Color fundus photograph.
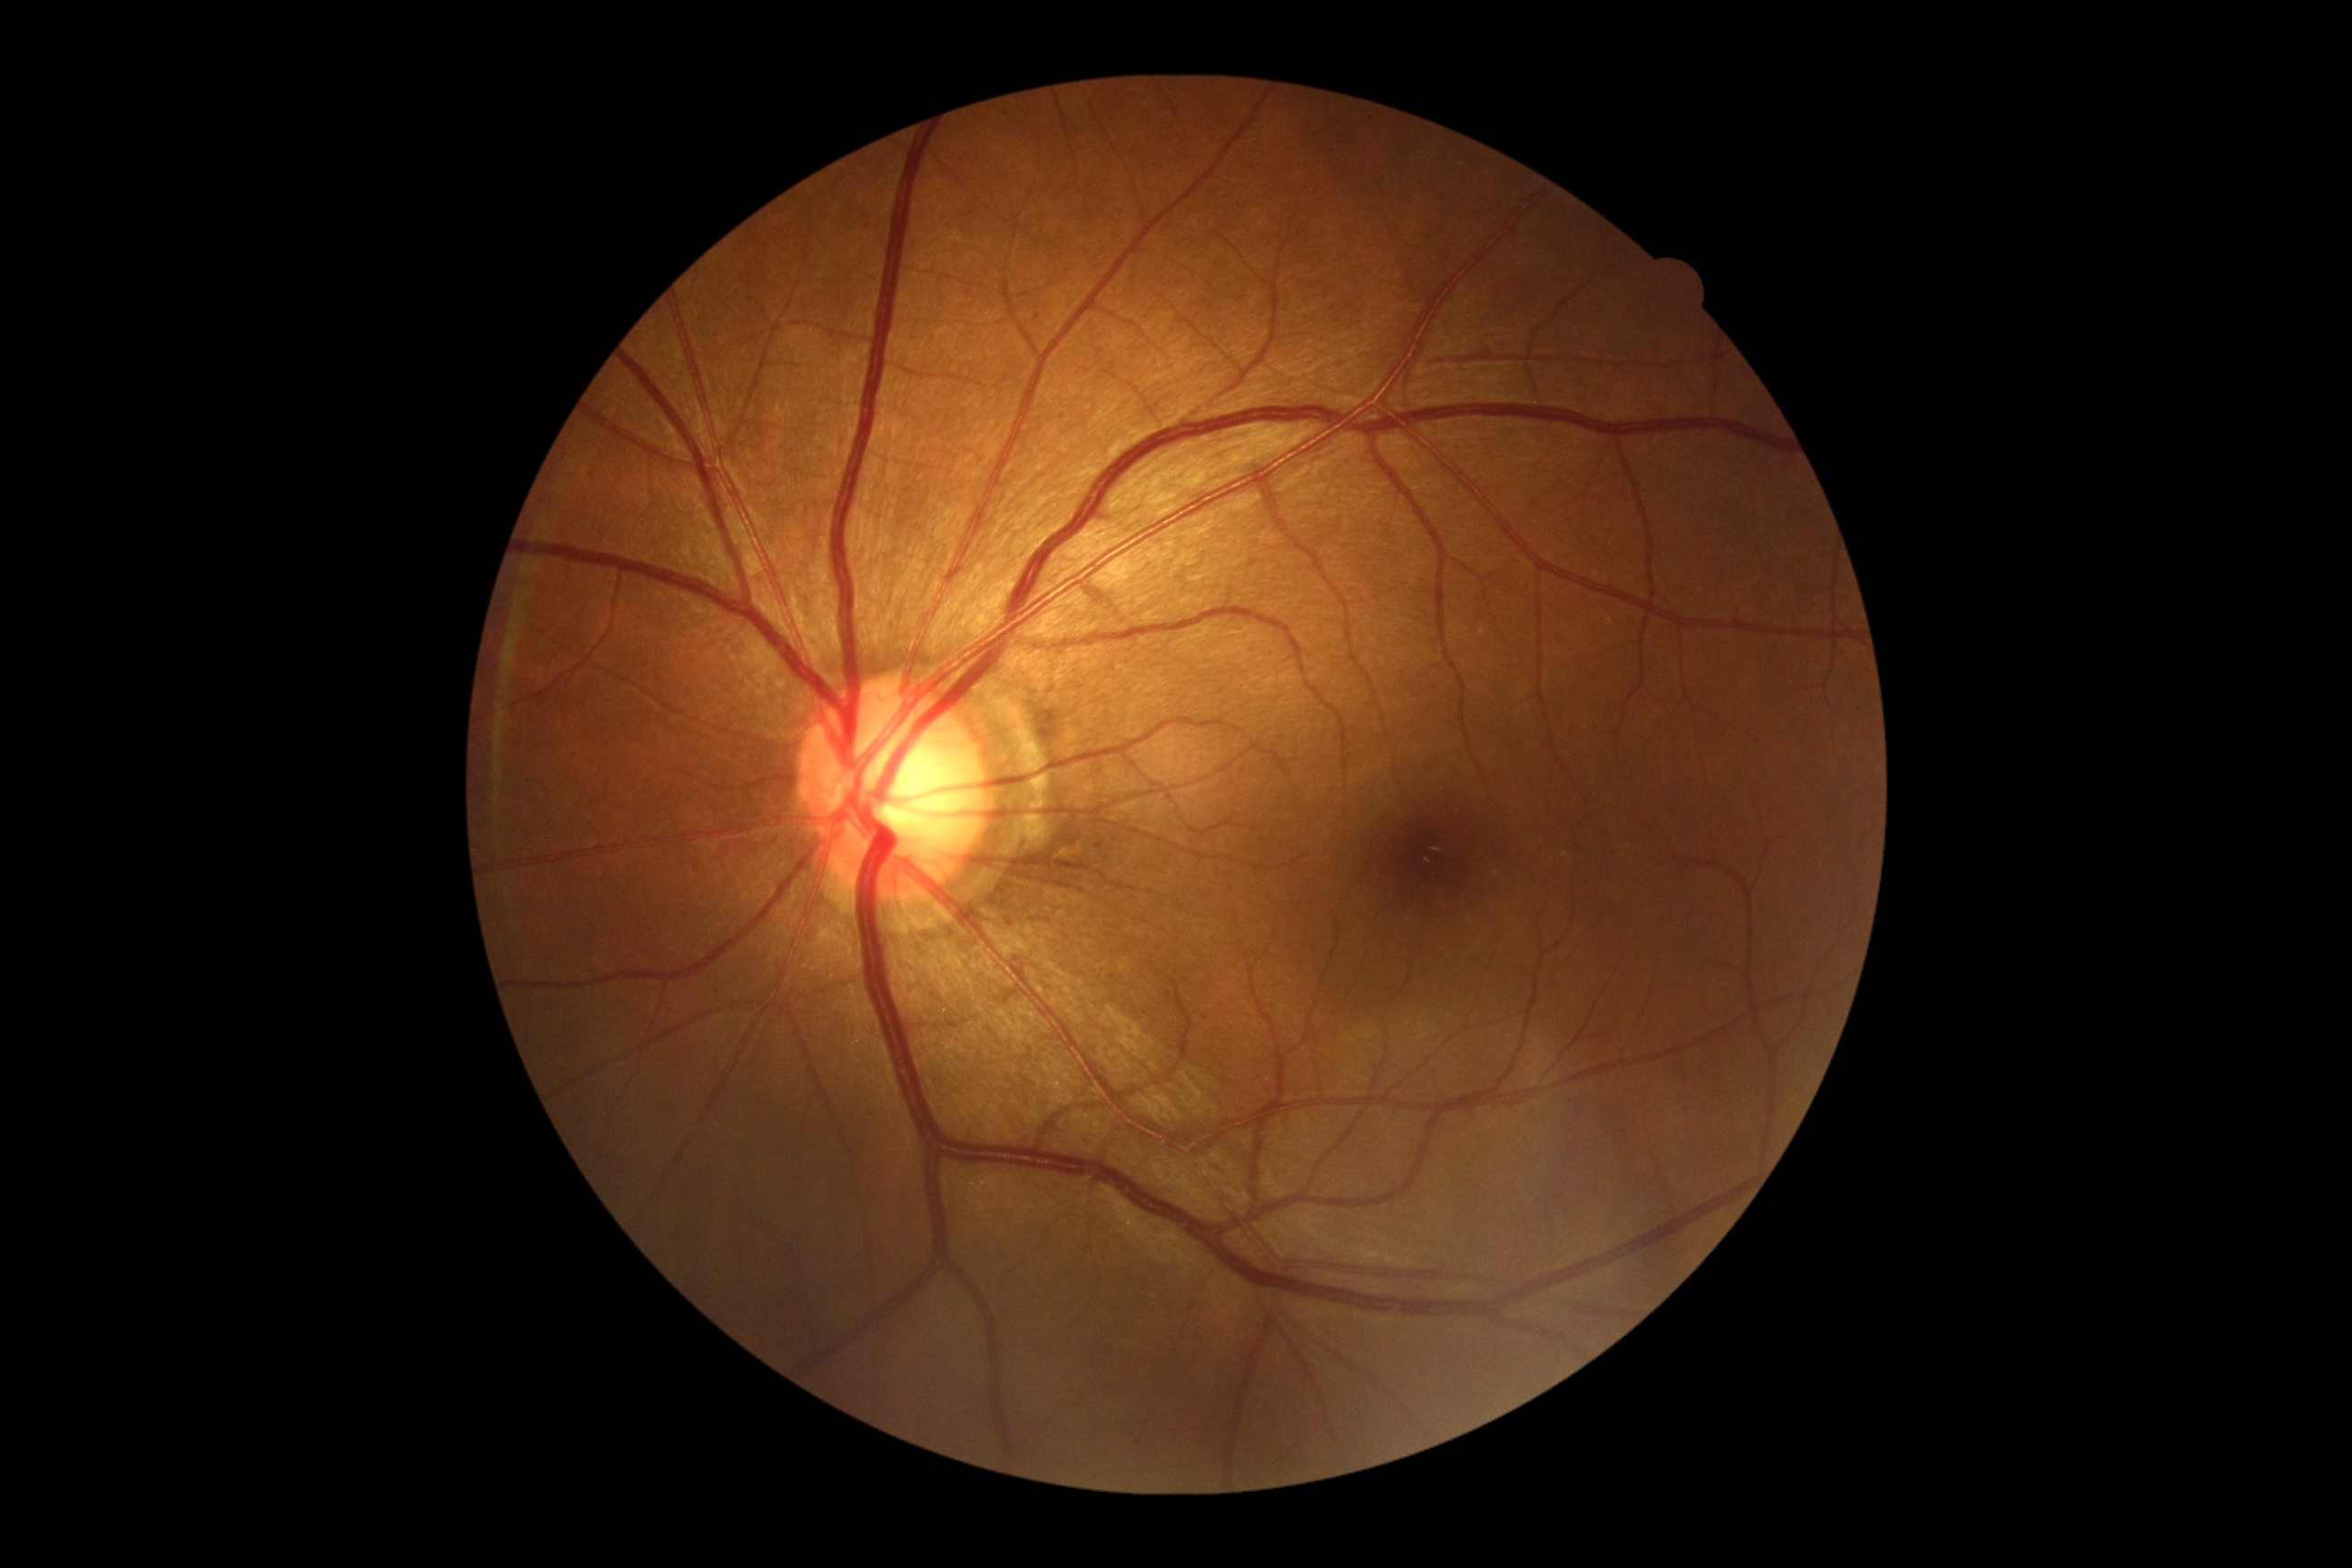 DR grade = no apparent retinopathy (0).